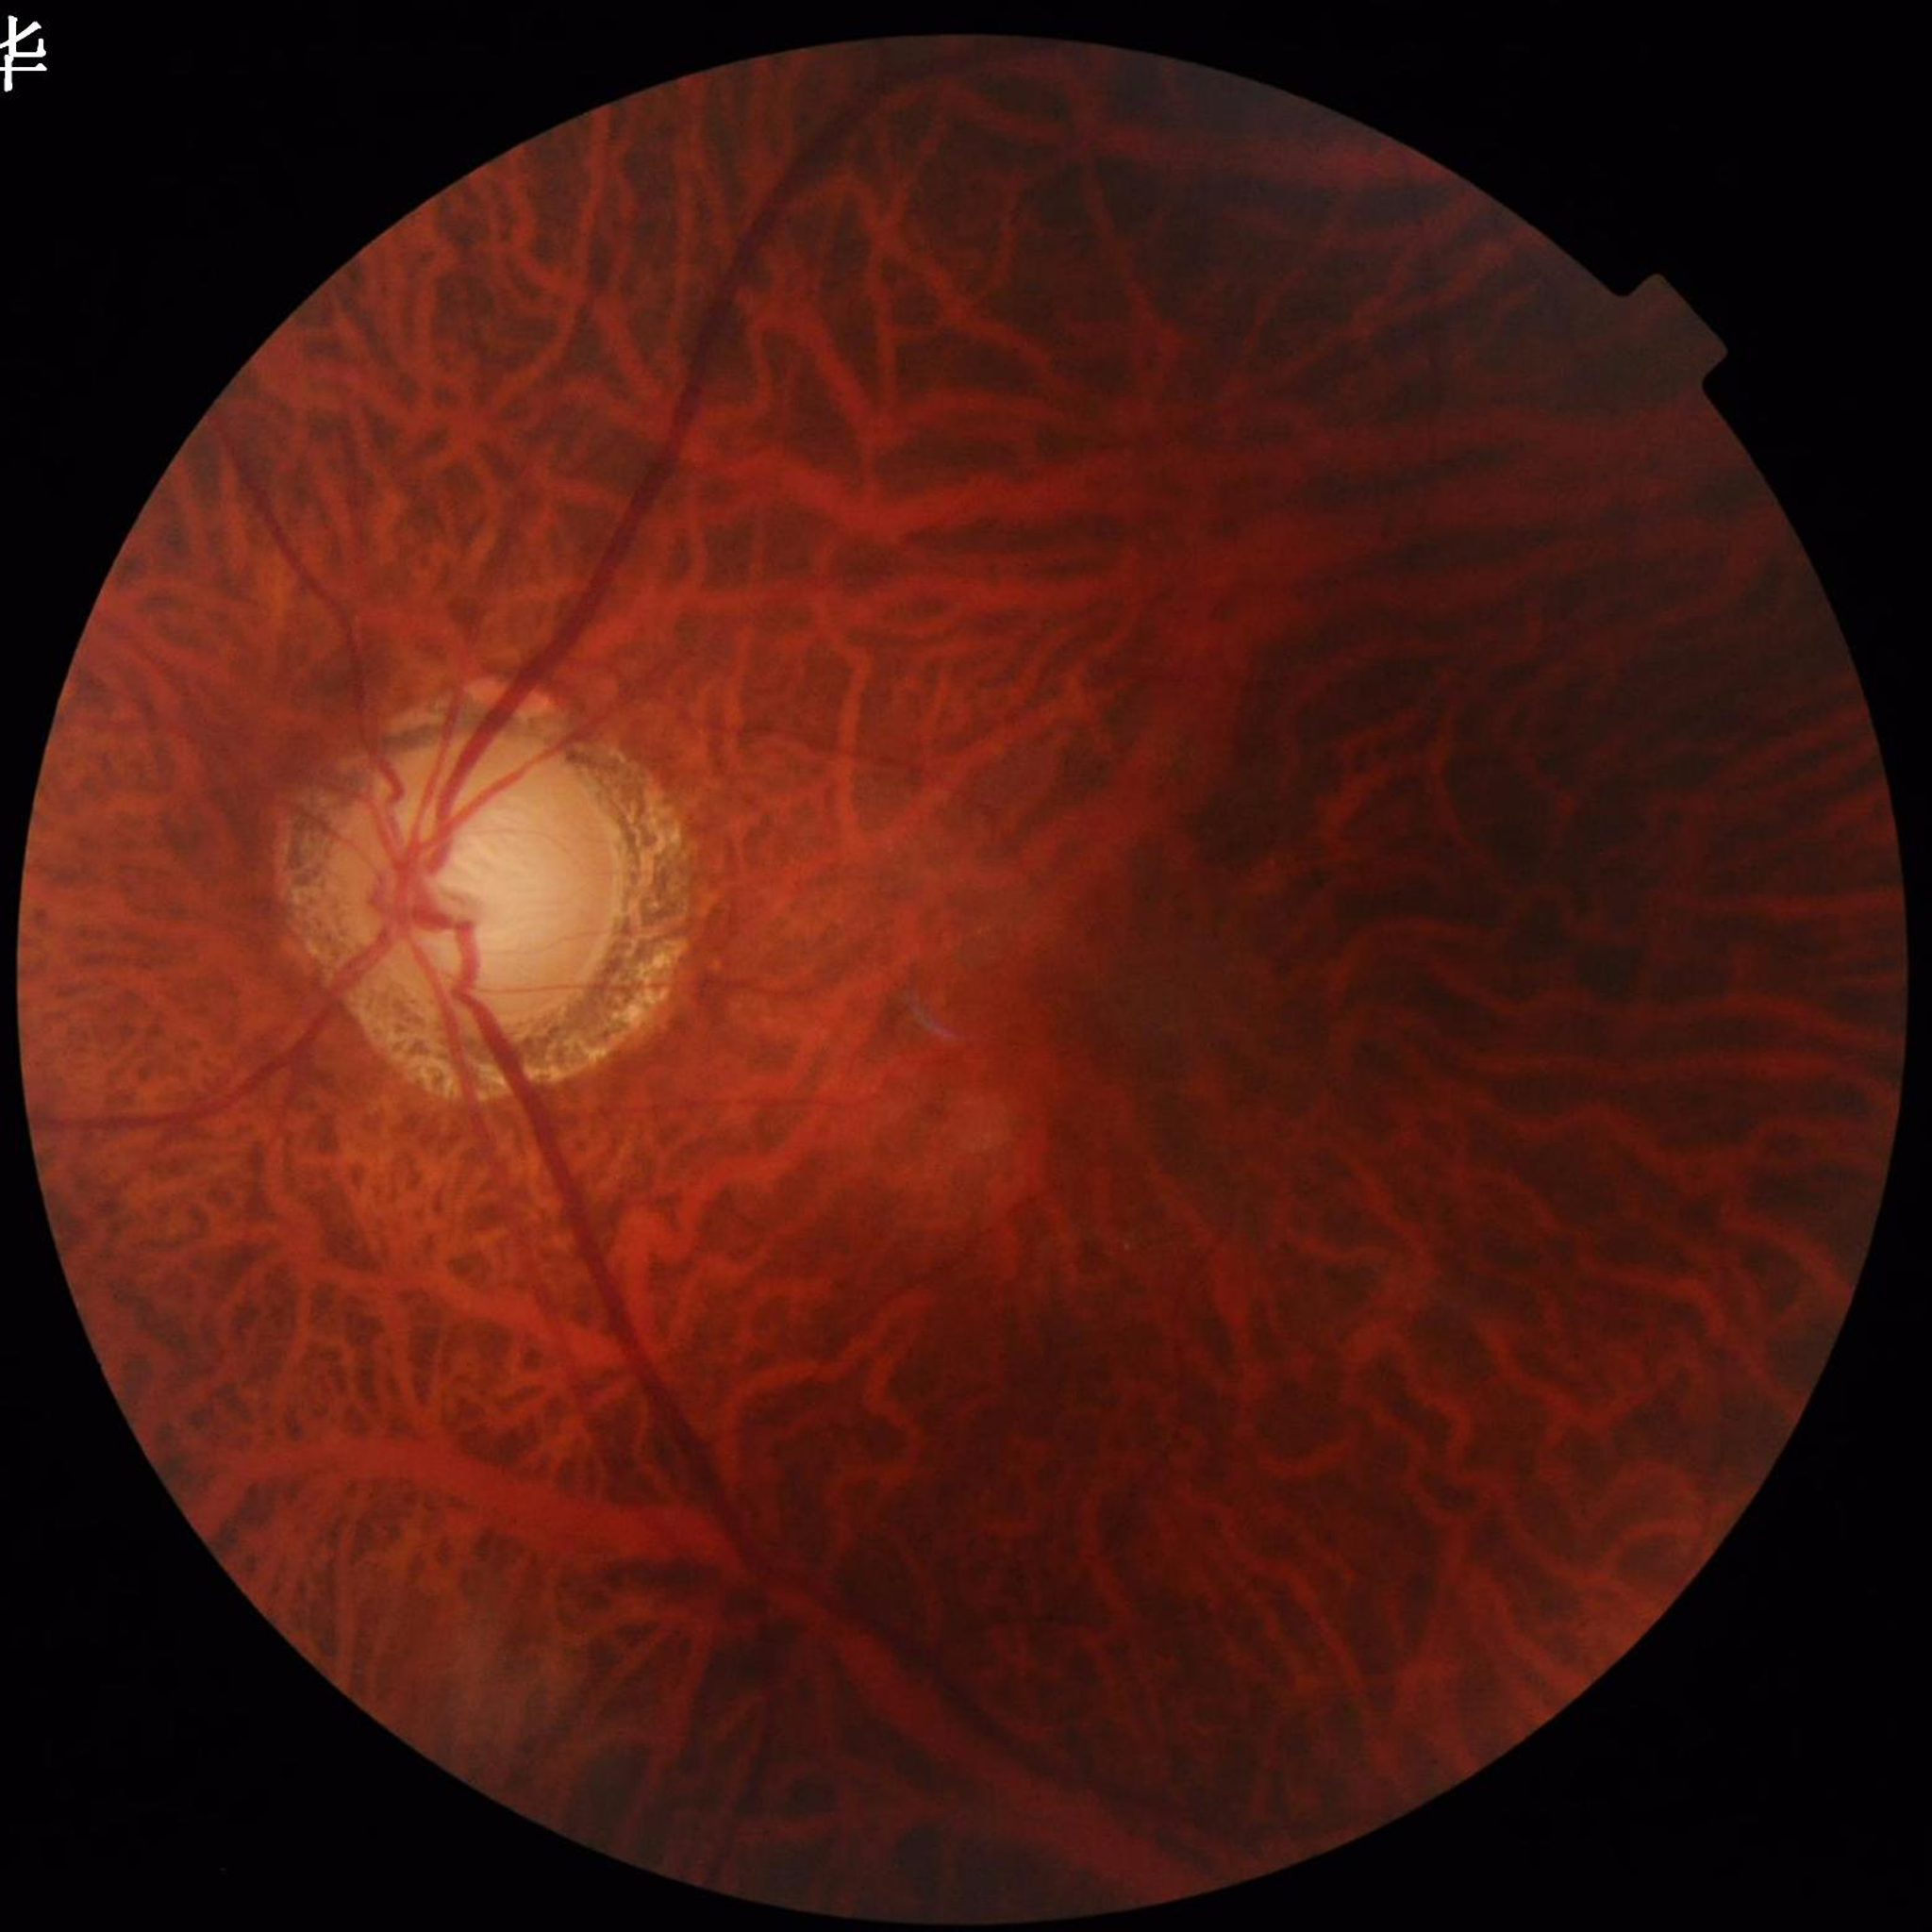

Quality assessment: issues noted — illumination/color distortion, blur. Fundus image of an eye with glaucoma.